2352x1568px, 45° FOV
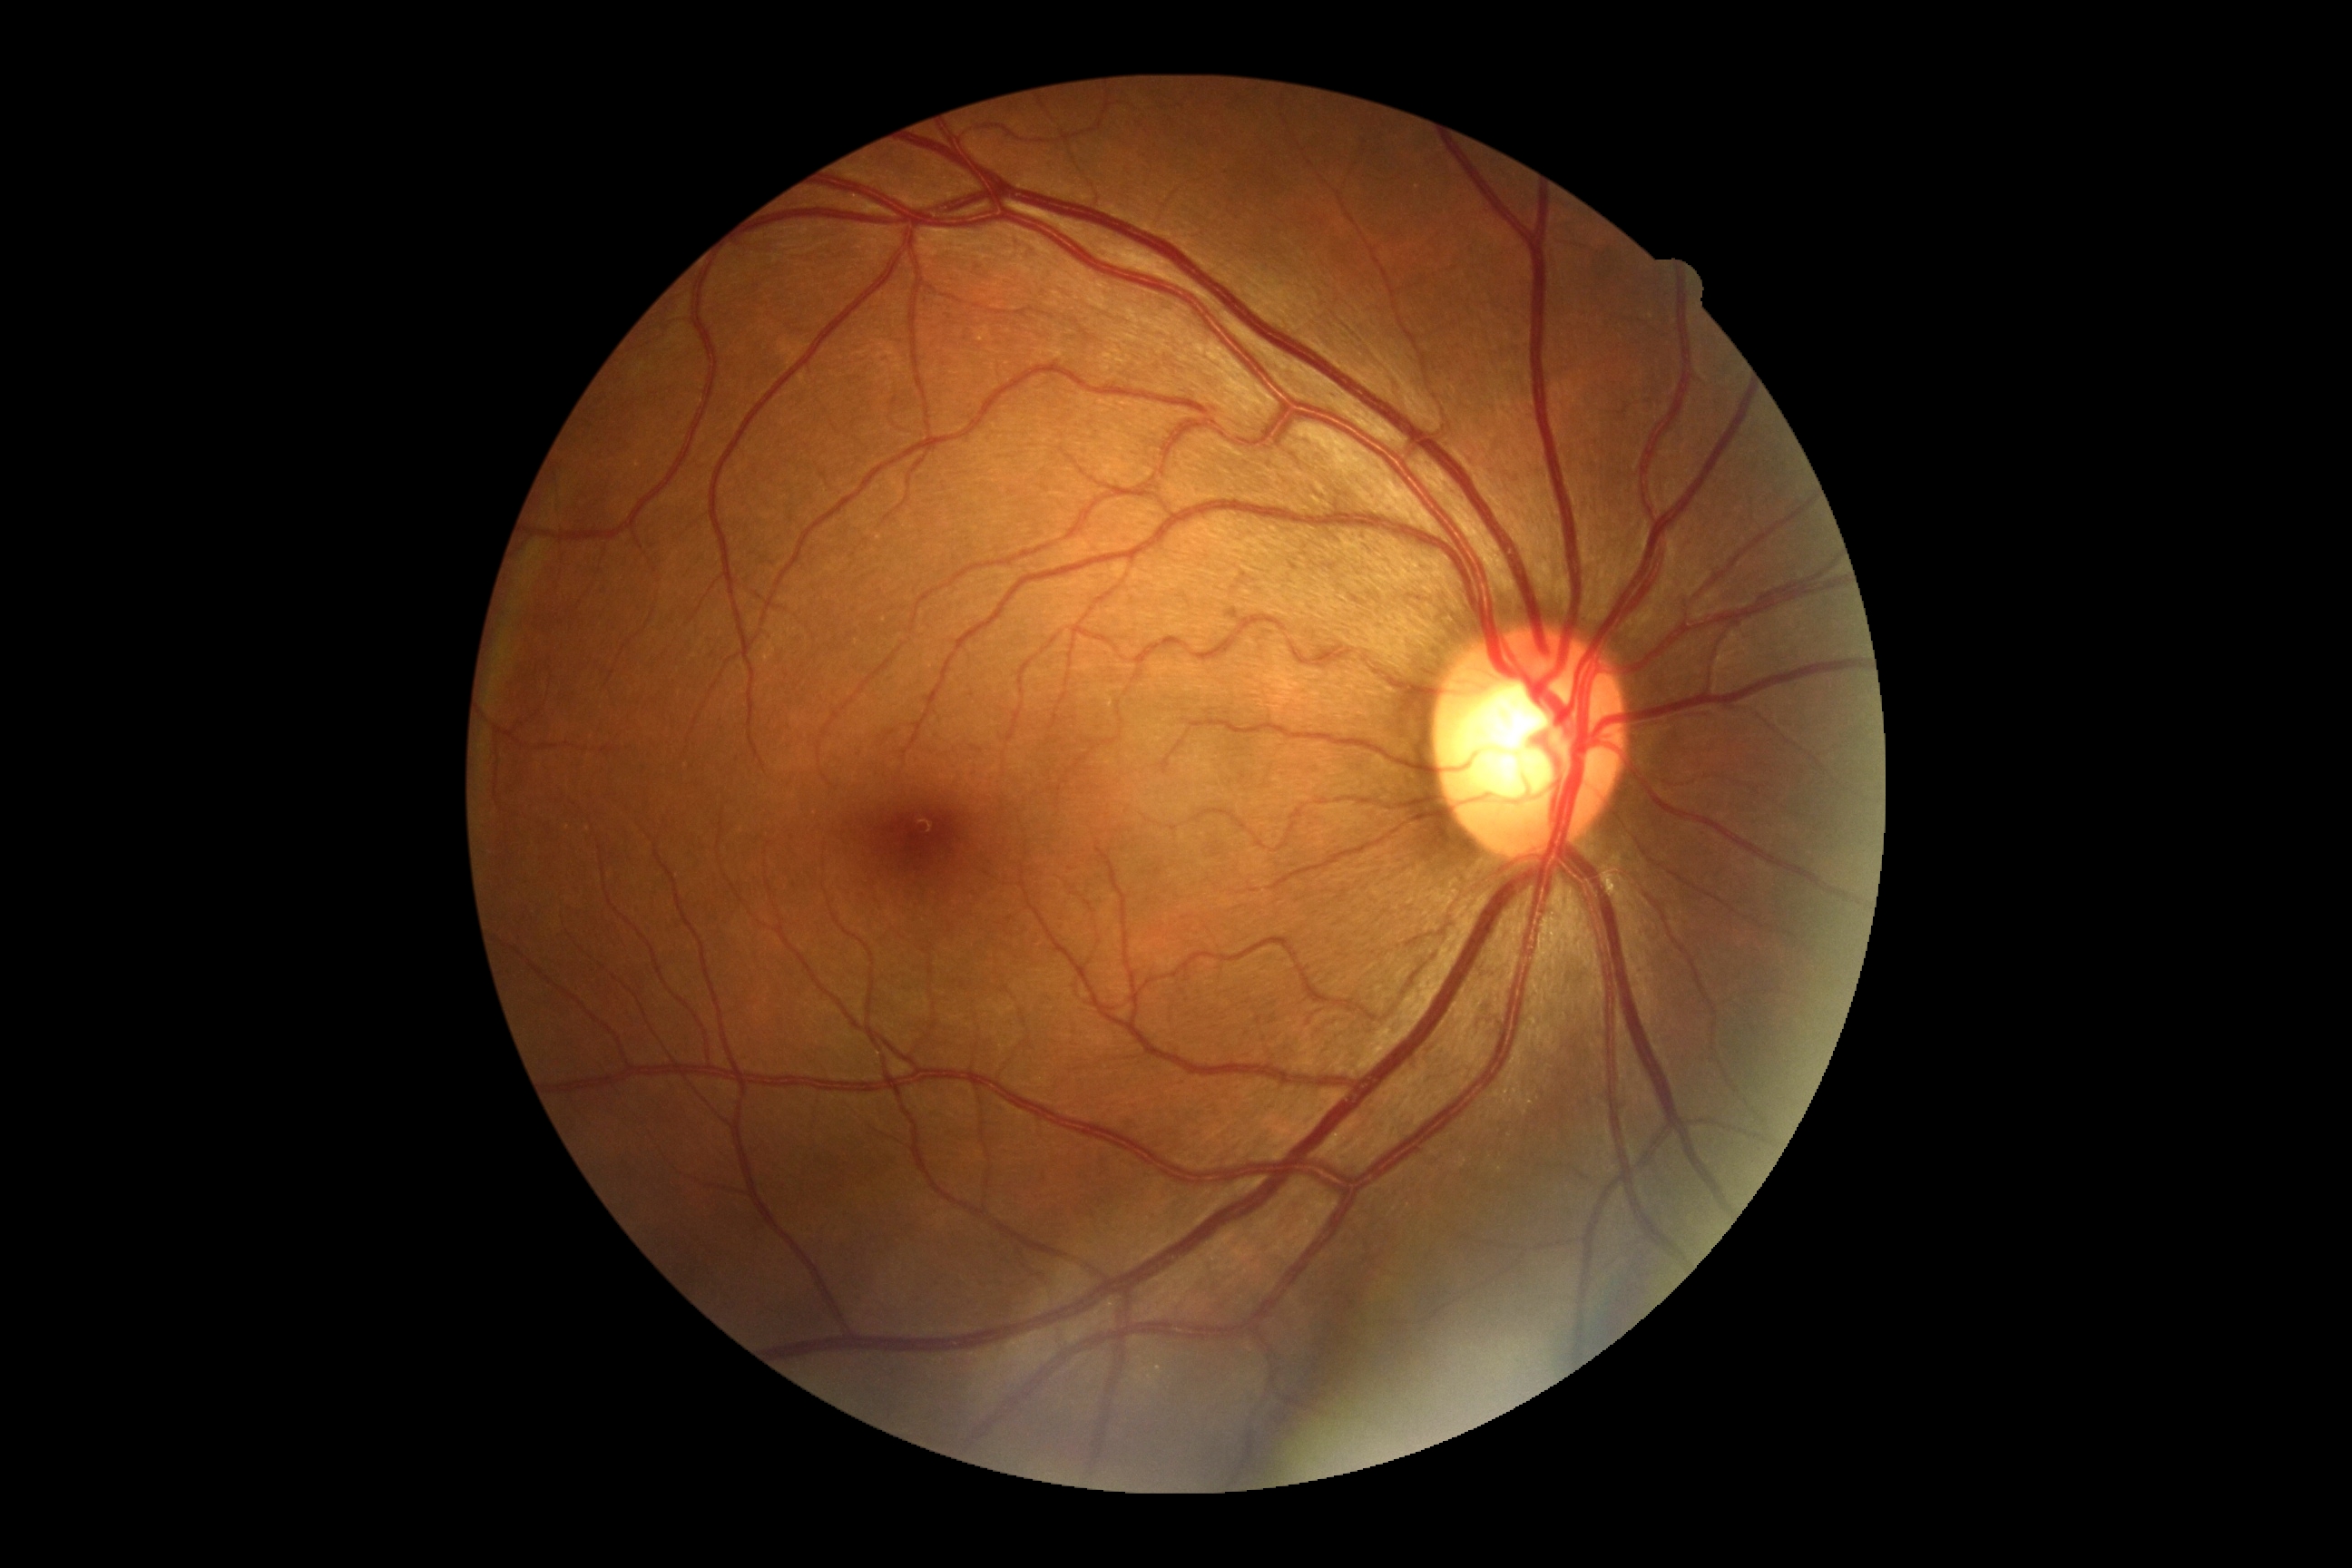 Diabetic retinopathy grade: 0.
No diabetic retinal disease findings.